Graded on the modified Davis scale
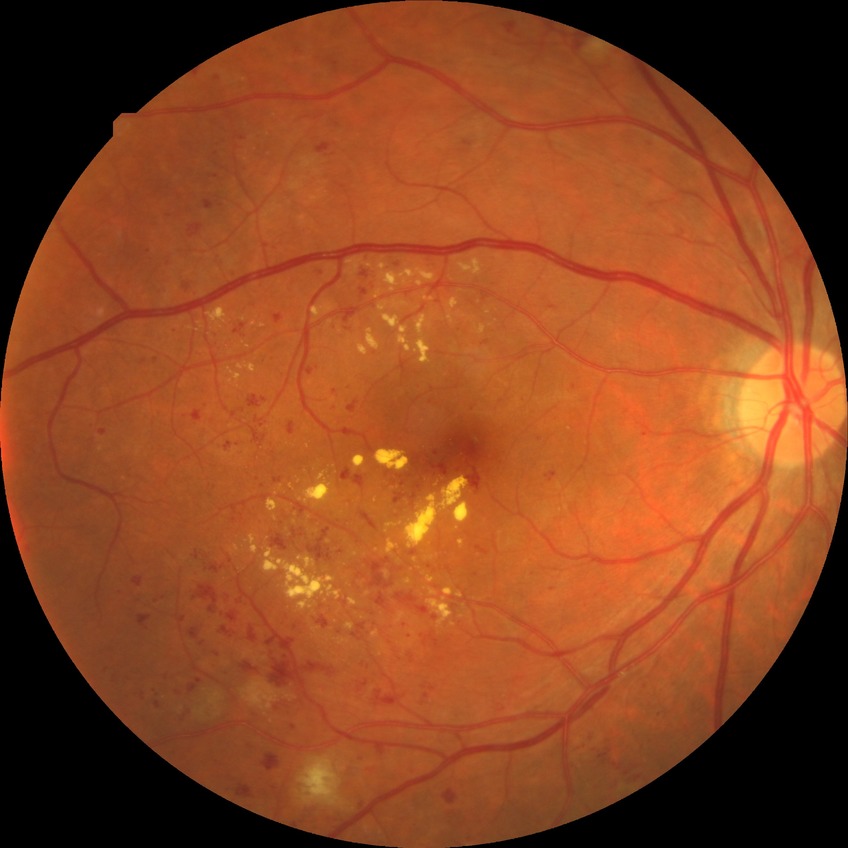
Diabetic retinopathy stage: pre-proliferative diabetic retinopathy.